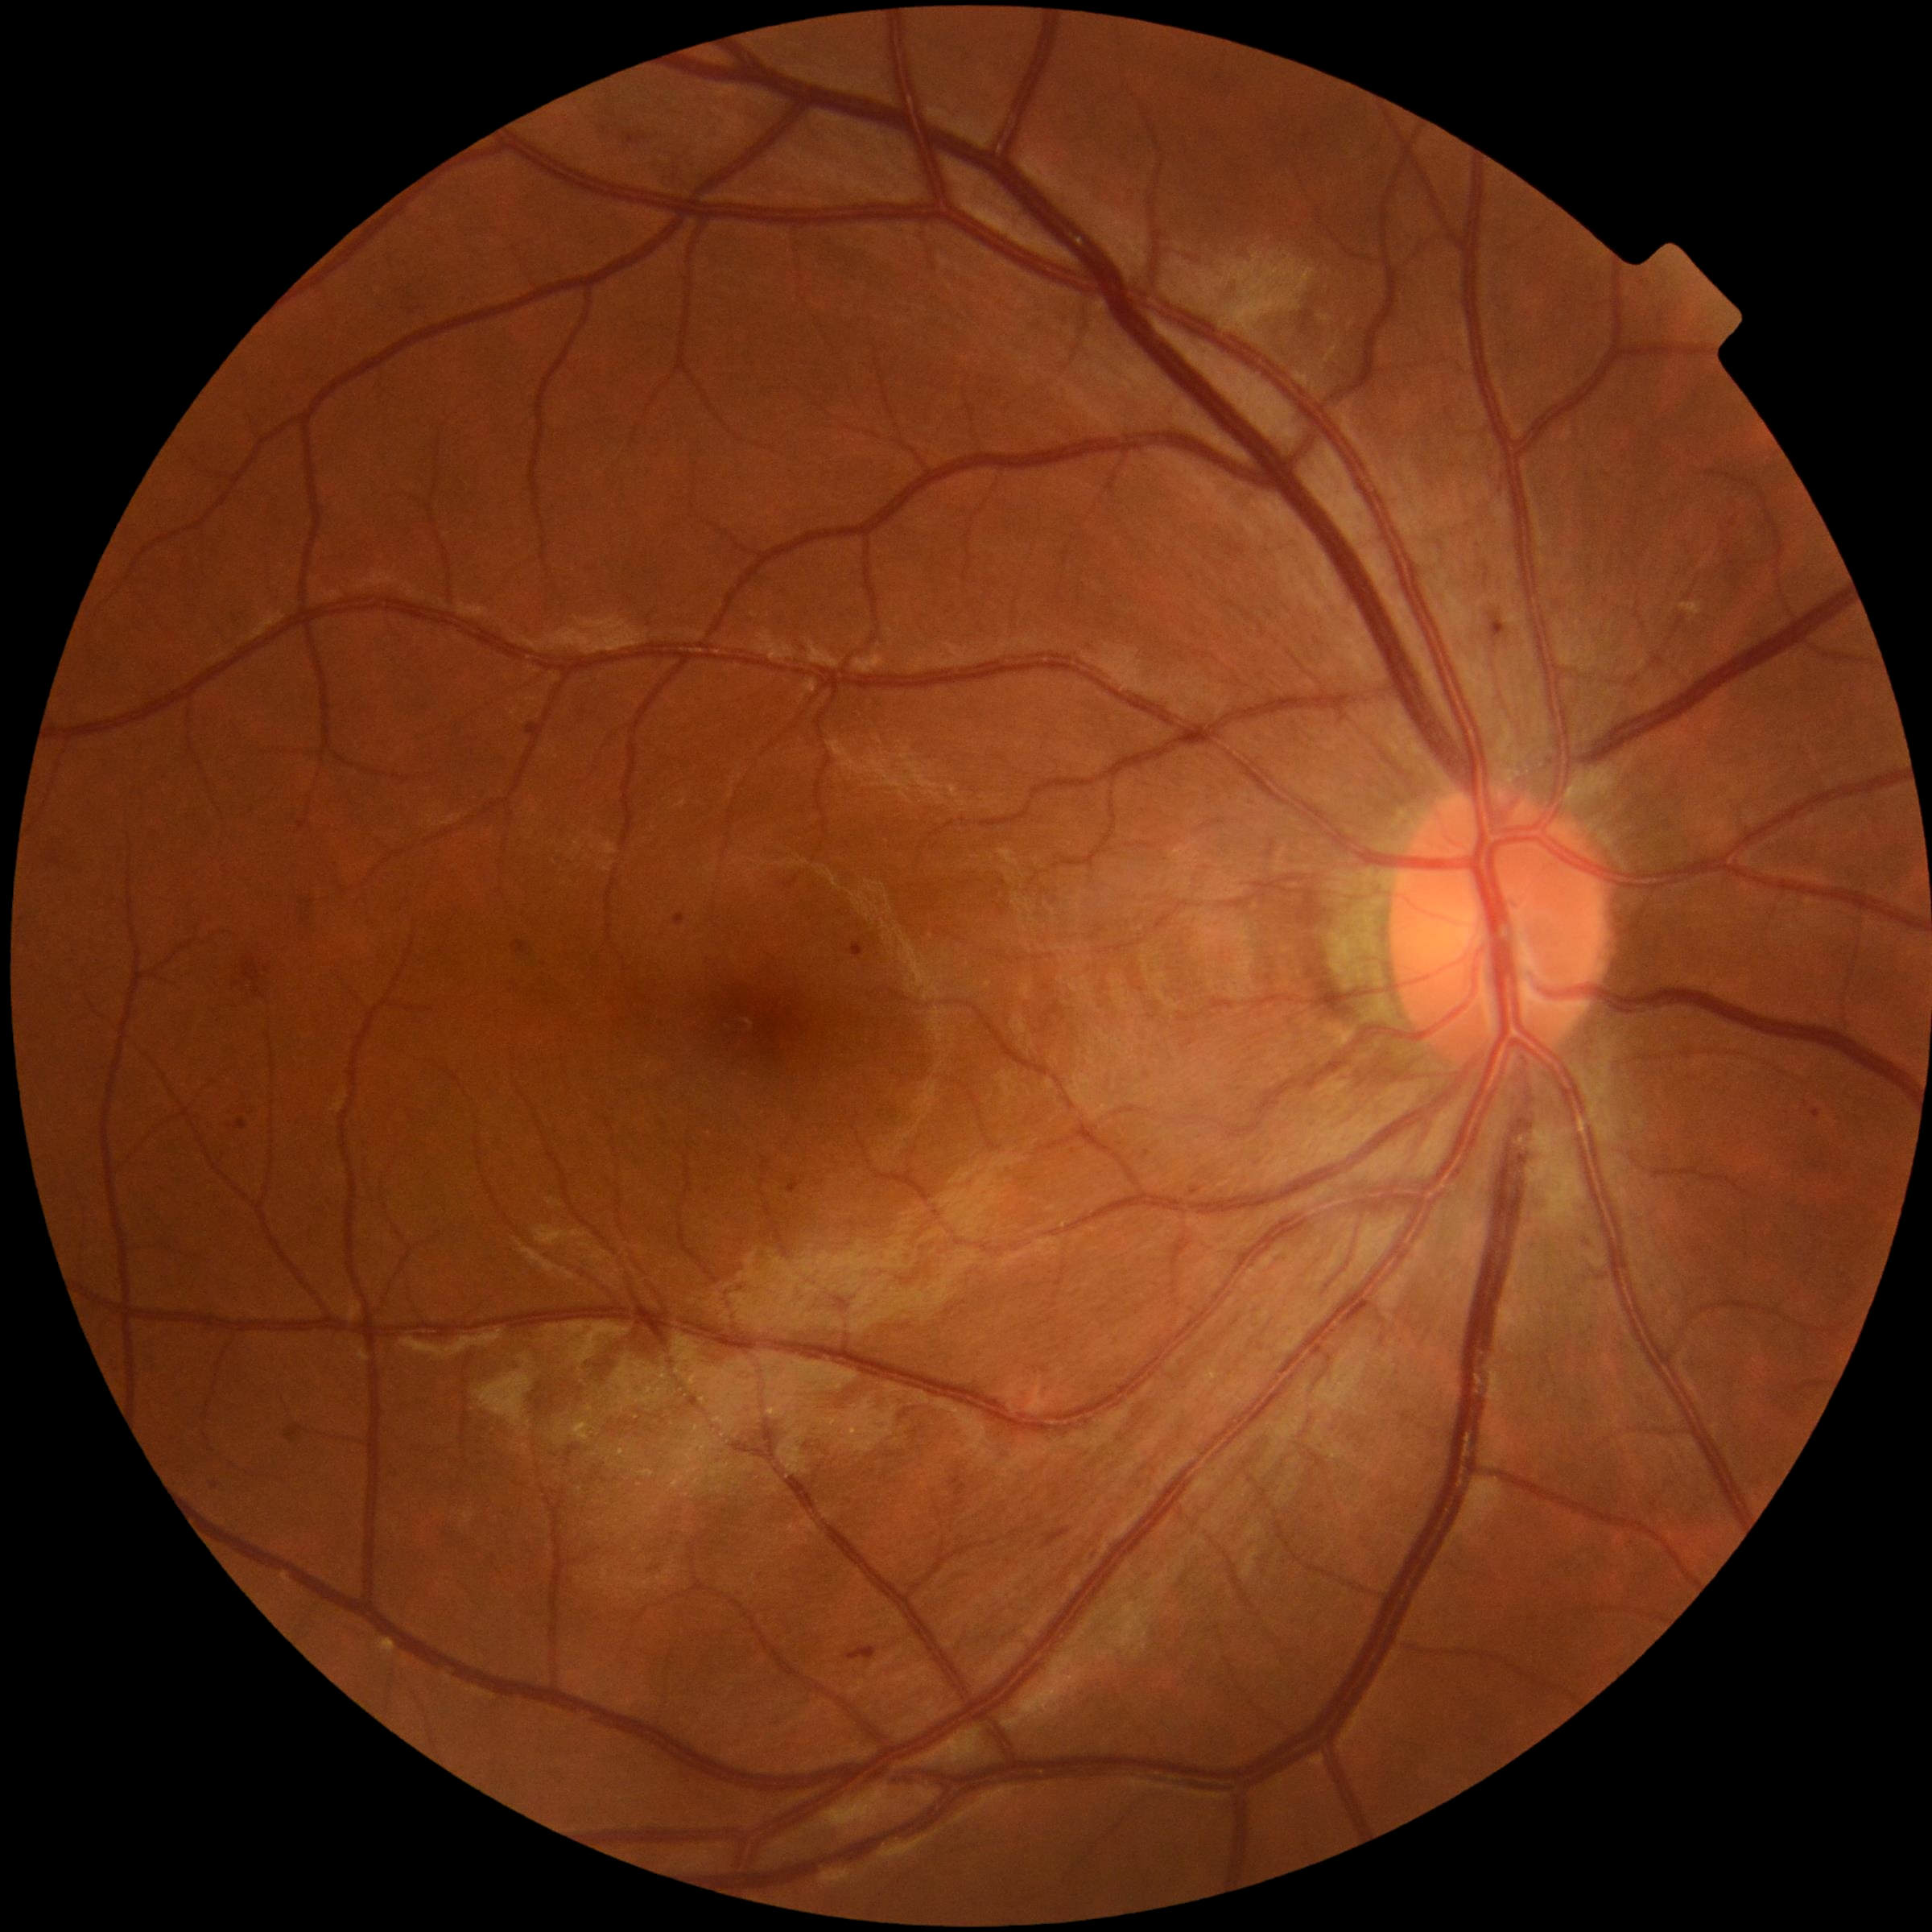
{"dr_grade":2,"dr_grade_name":"moderate NPDR","lesions":{"he":[[848,1647,877,1661],[234,981,242,987],[264,964,271,972],[243,957,264,998],[1043,1529,1071,1548],[625,133,647,147]],"se":null,"ex":null,"ma":[[849,943,865,959],[675,914,687,927],[1145,1150,1150,1158],[1492,613,1507,638],[1576,1231,1593,1249],[1190,1187,1200,1195],[229,1118,249,1129],[1813,1108,1820,1118],[299,898,315,912],[787,1179,801,1193],[514,940,529,953],[526,722,543,737]],"ma_small":[[1308,138],[216,1487]]}}